Phoenix ICON wide-field infant fundus image.
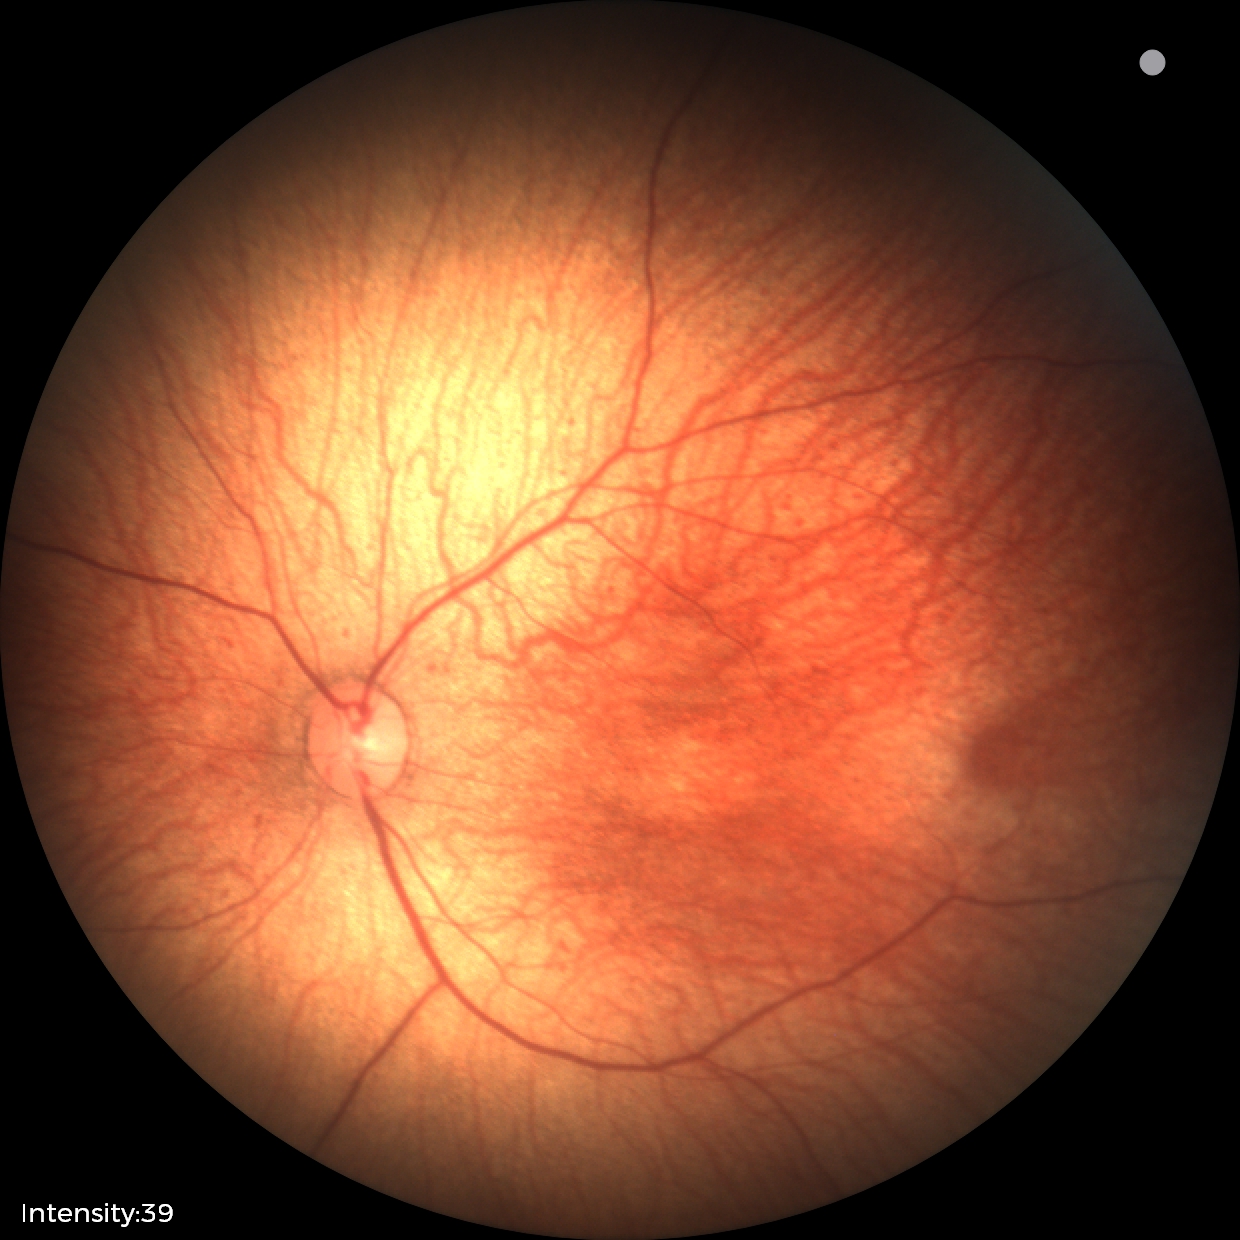
Normal screening examination.